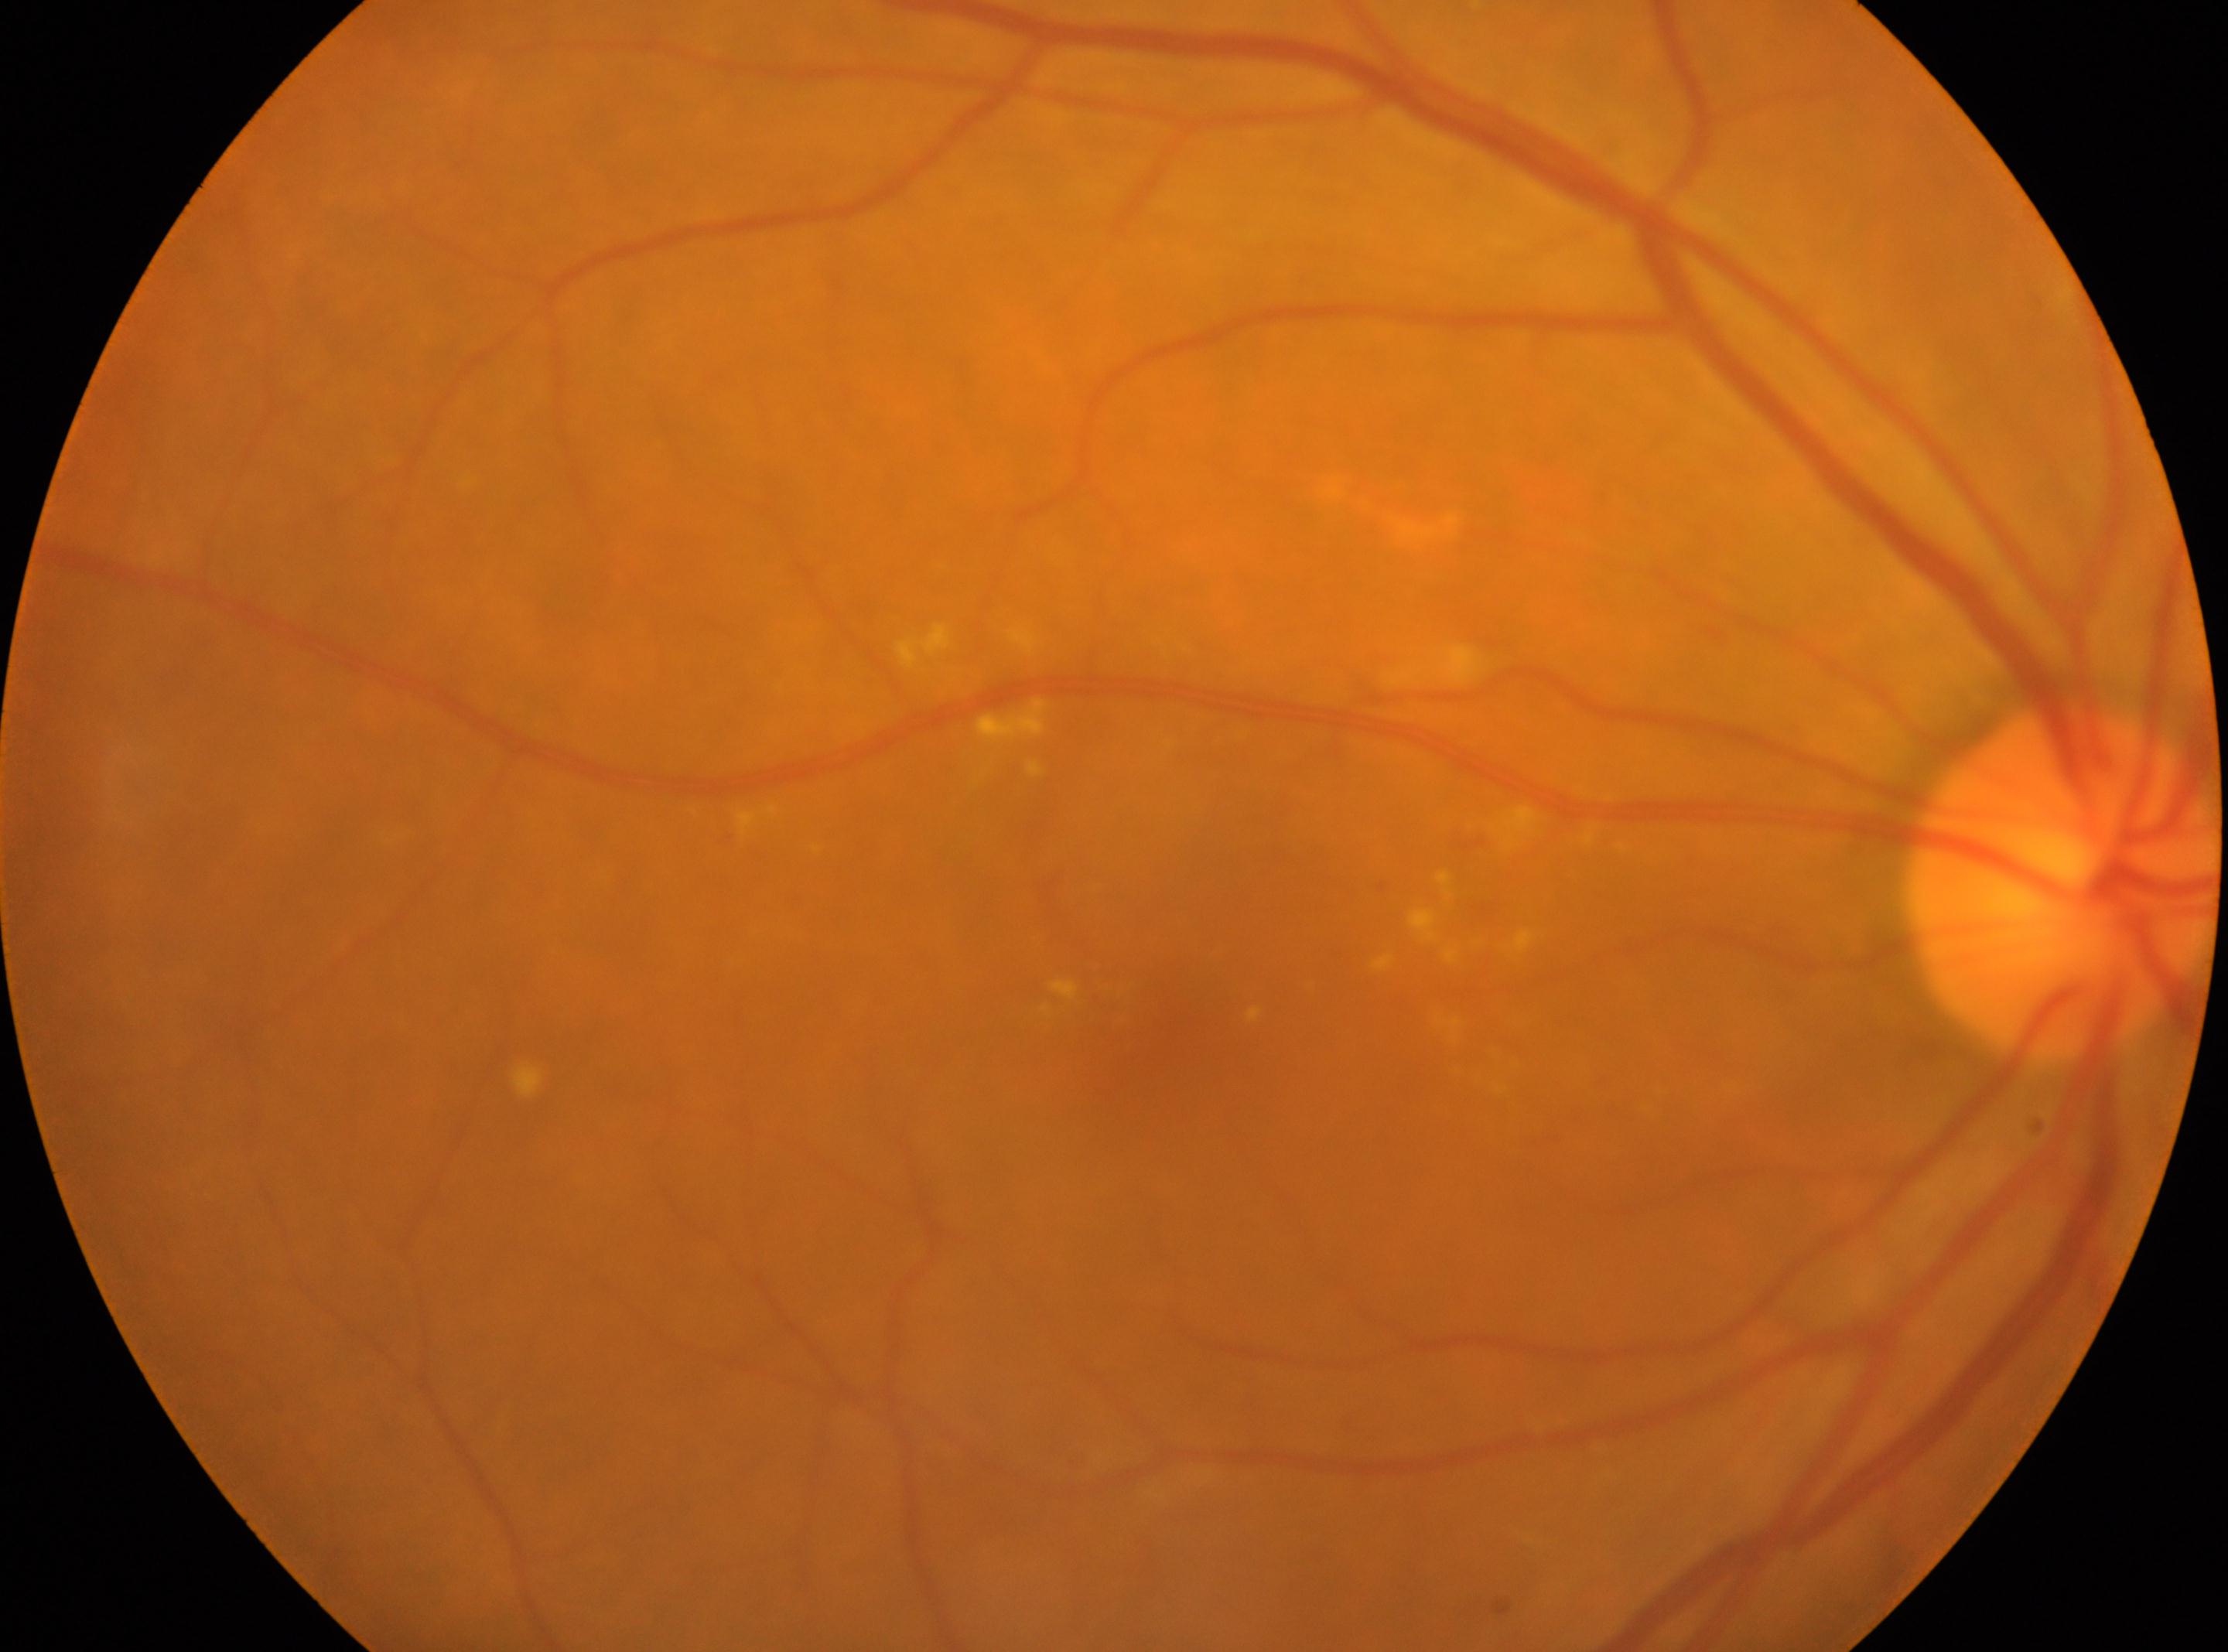

Diabetic retinopathy (DR) is grade 2 (moderate NPDR).
Fovea located at (x: 1179, y: 1046).
This is the OD.
The optic nerve head is at (x: 2062, y: 883).